Wide-field contact fundus photograph of an infant.
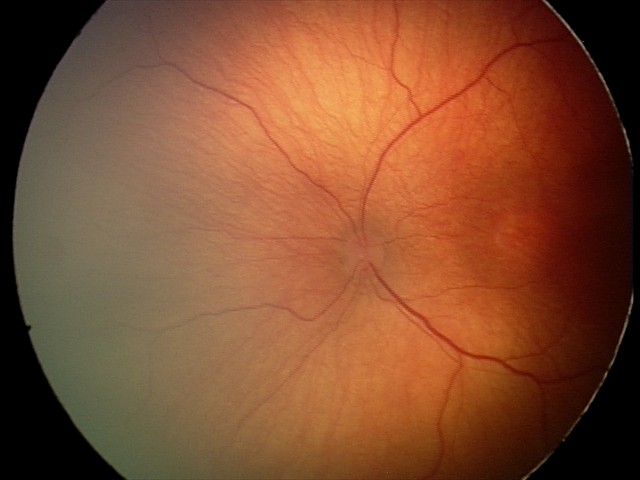

From an examination with diagnosis of ROP stage 2.
Plus disease absent.